Pediatric retinal photograph (wide-field):
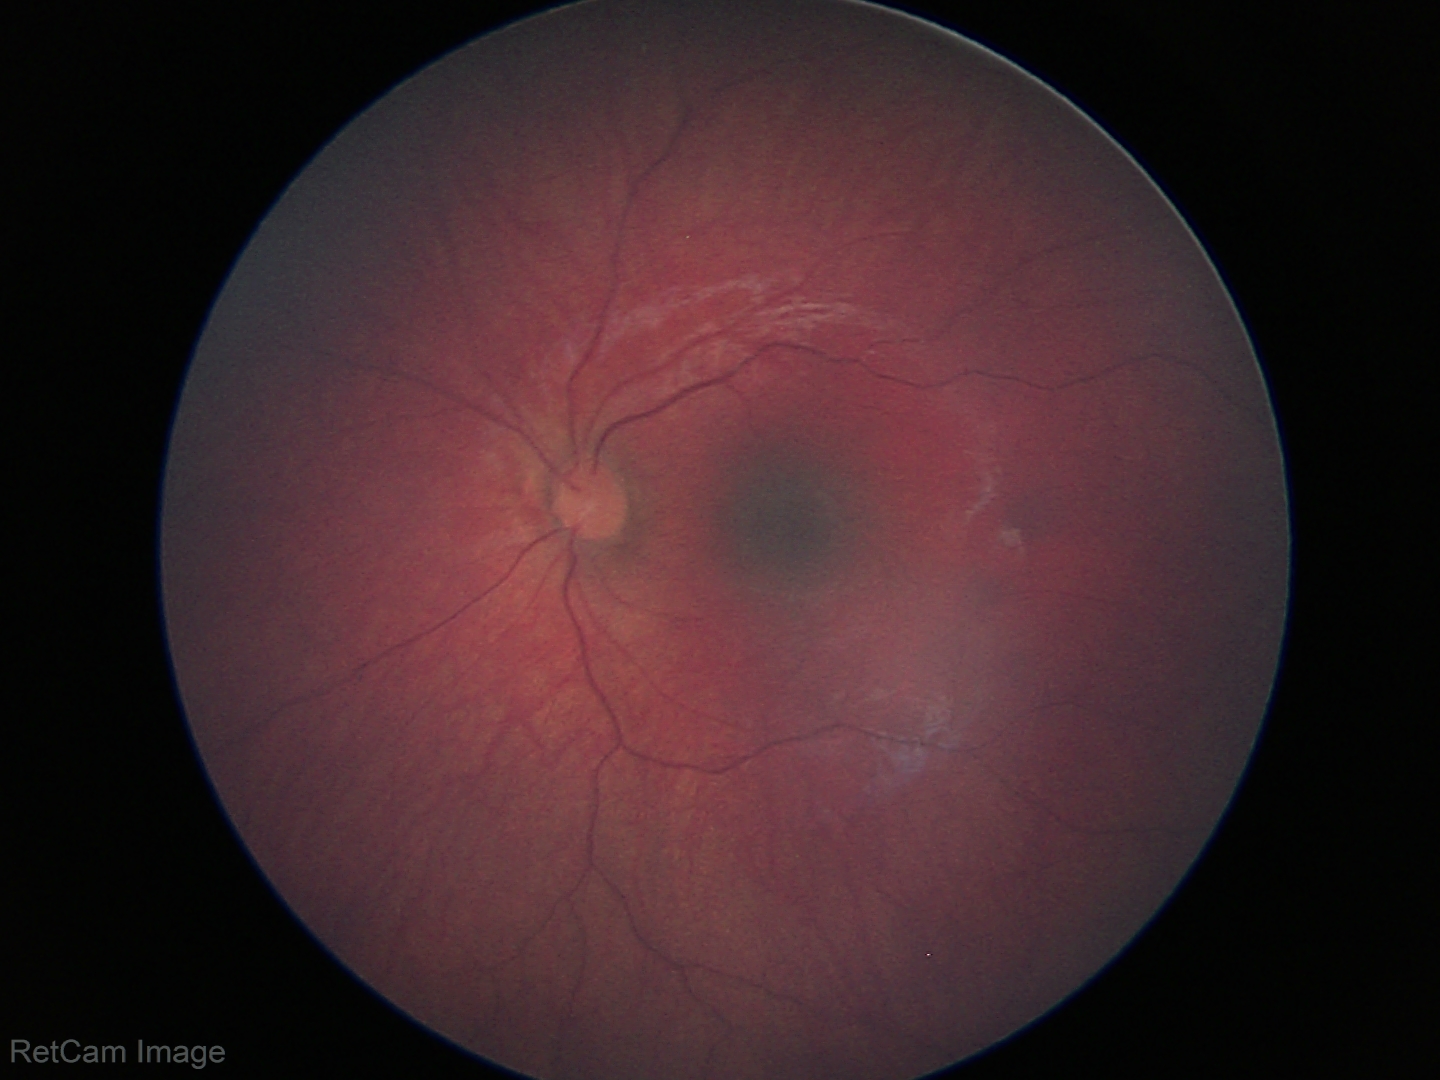
Normal screening examination.